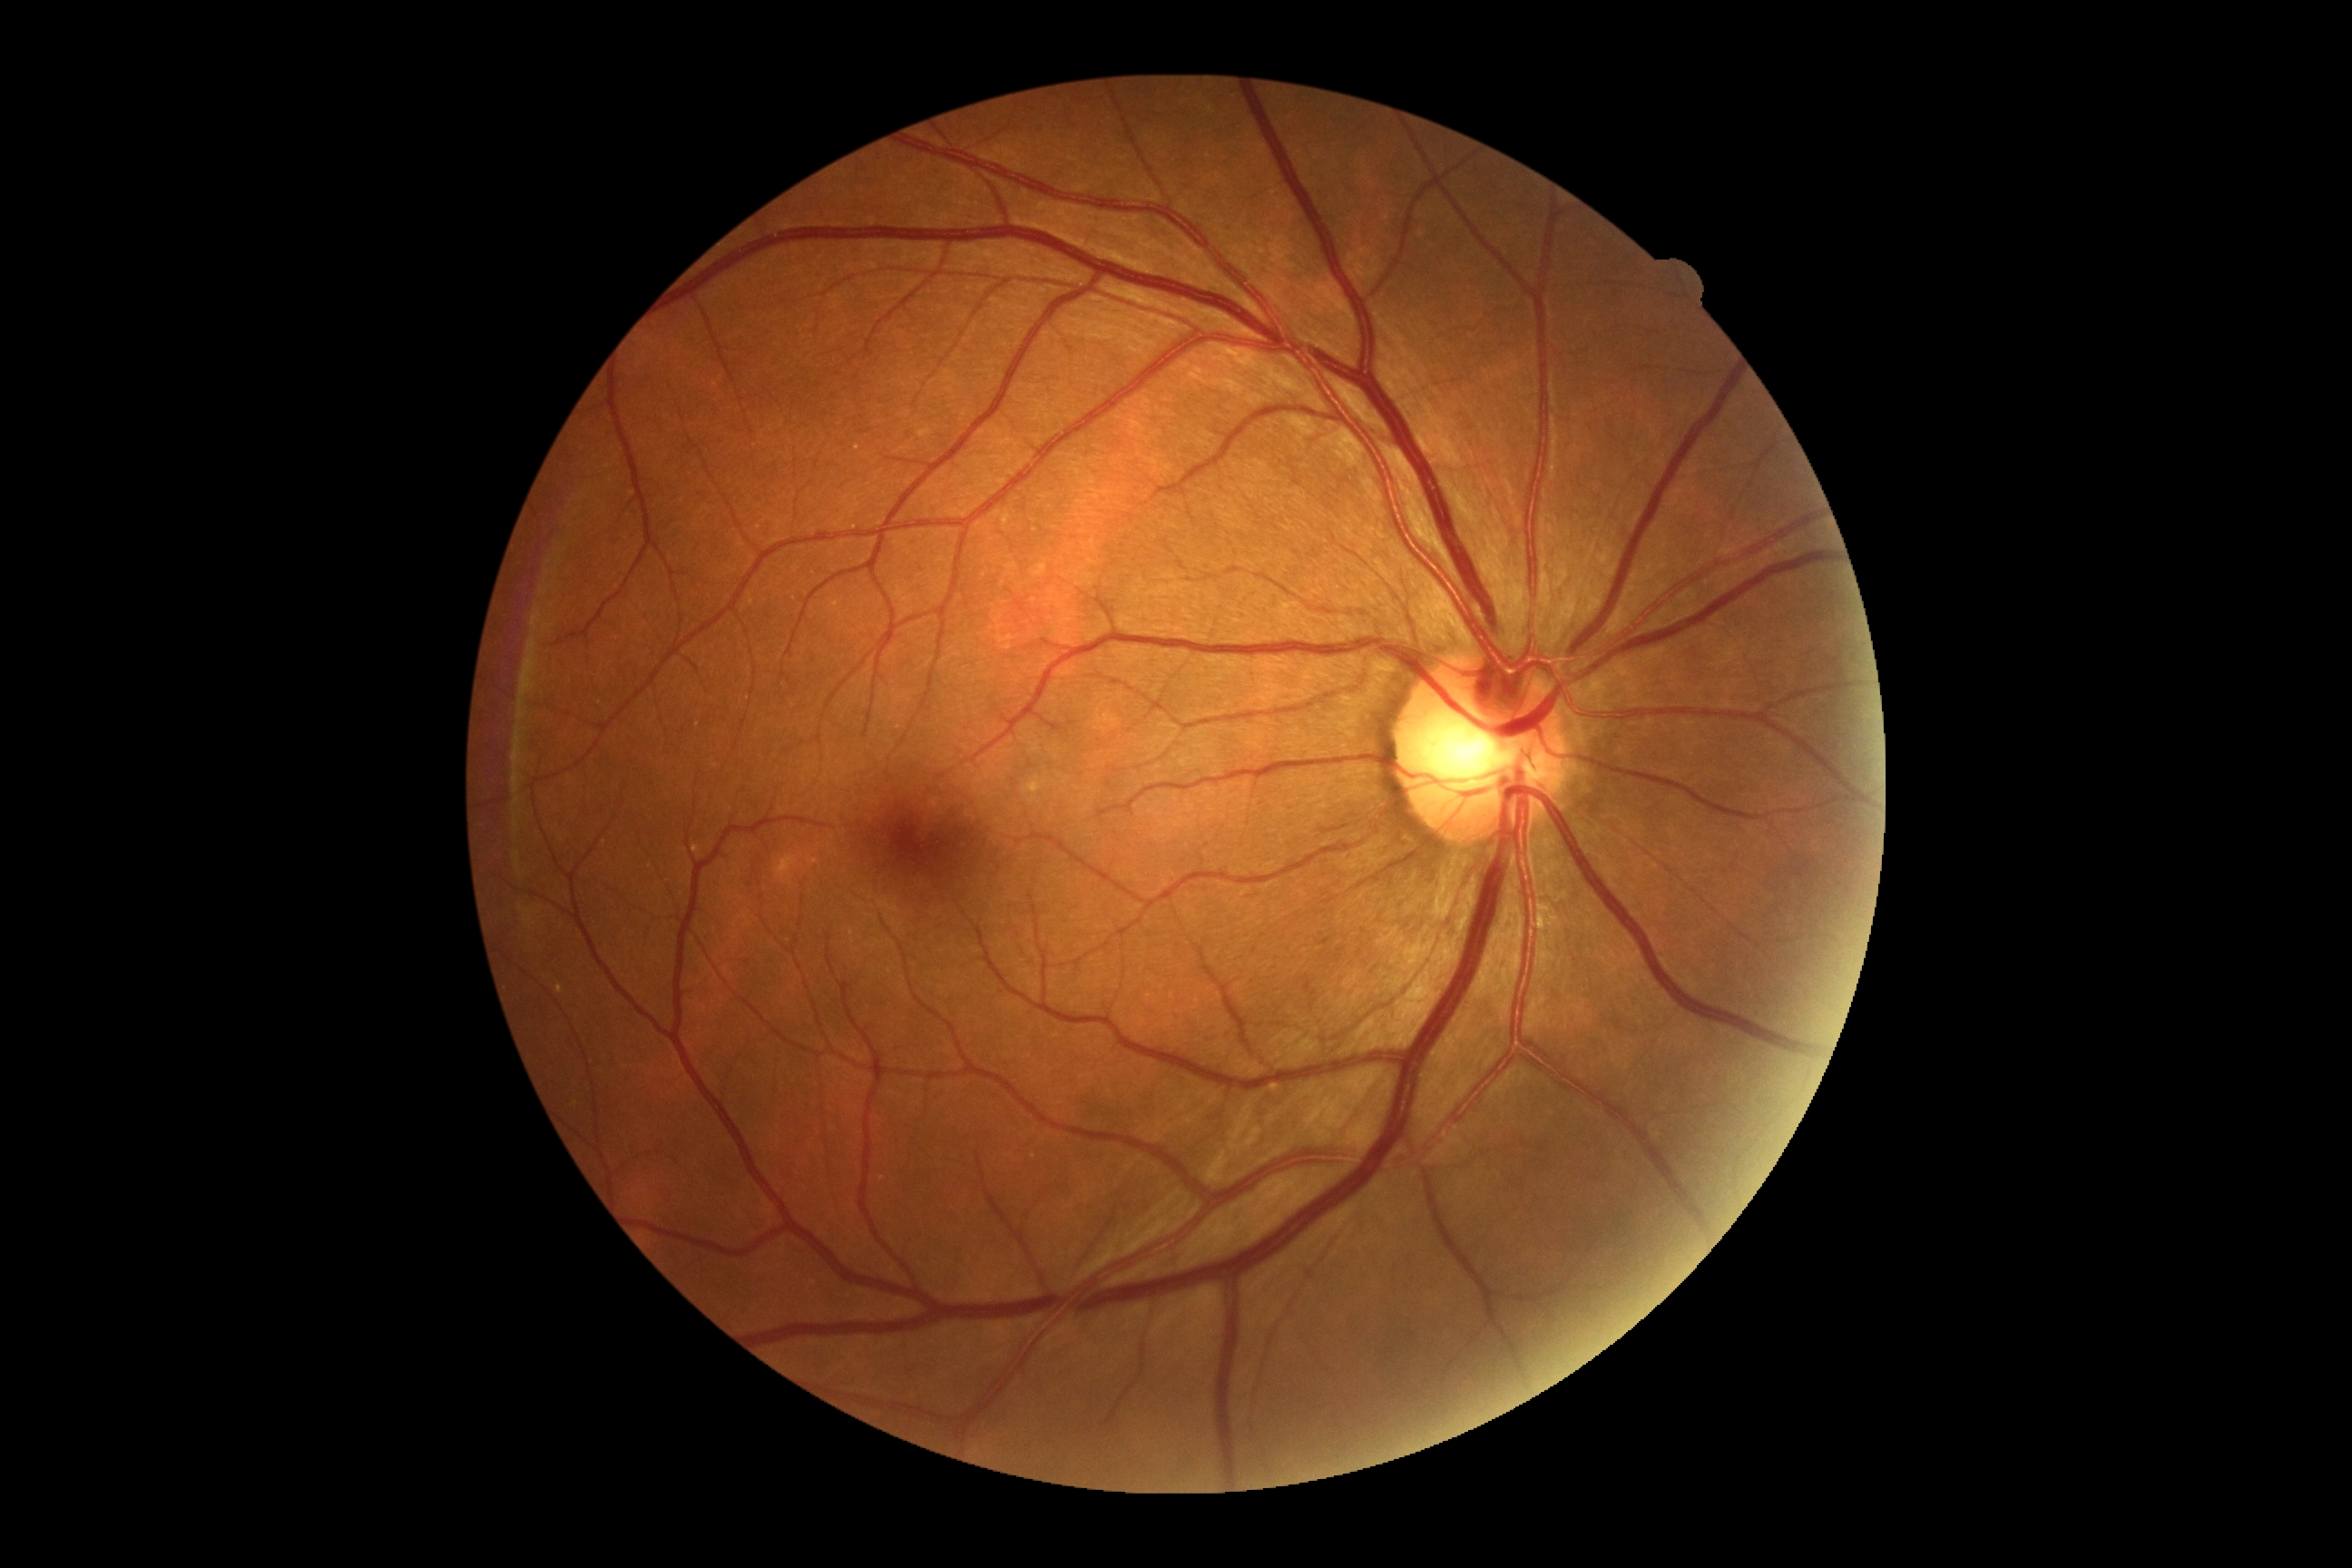 DR grade is 0. No diabetic retinal disease findings.